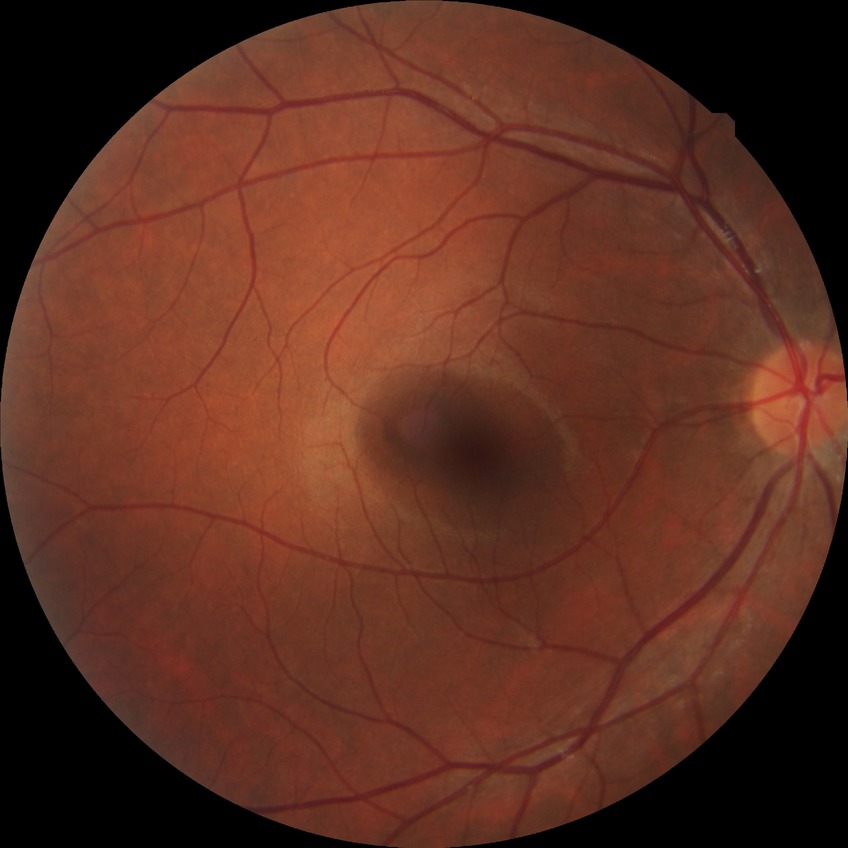 Assessment:
* diabetic retinopathy (DR): NDR (no diabetic retinopathy)